CFP · acquired with a Remidio Fundus on Phone (FOP) camera.
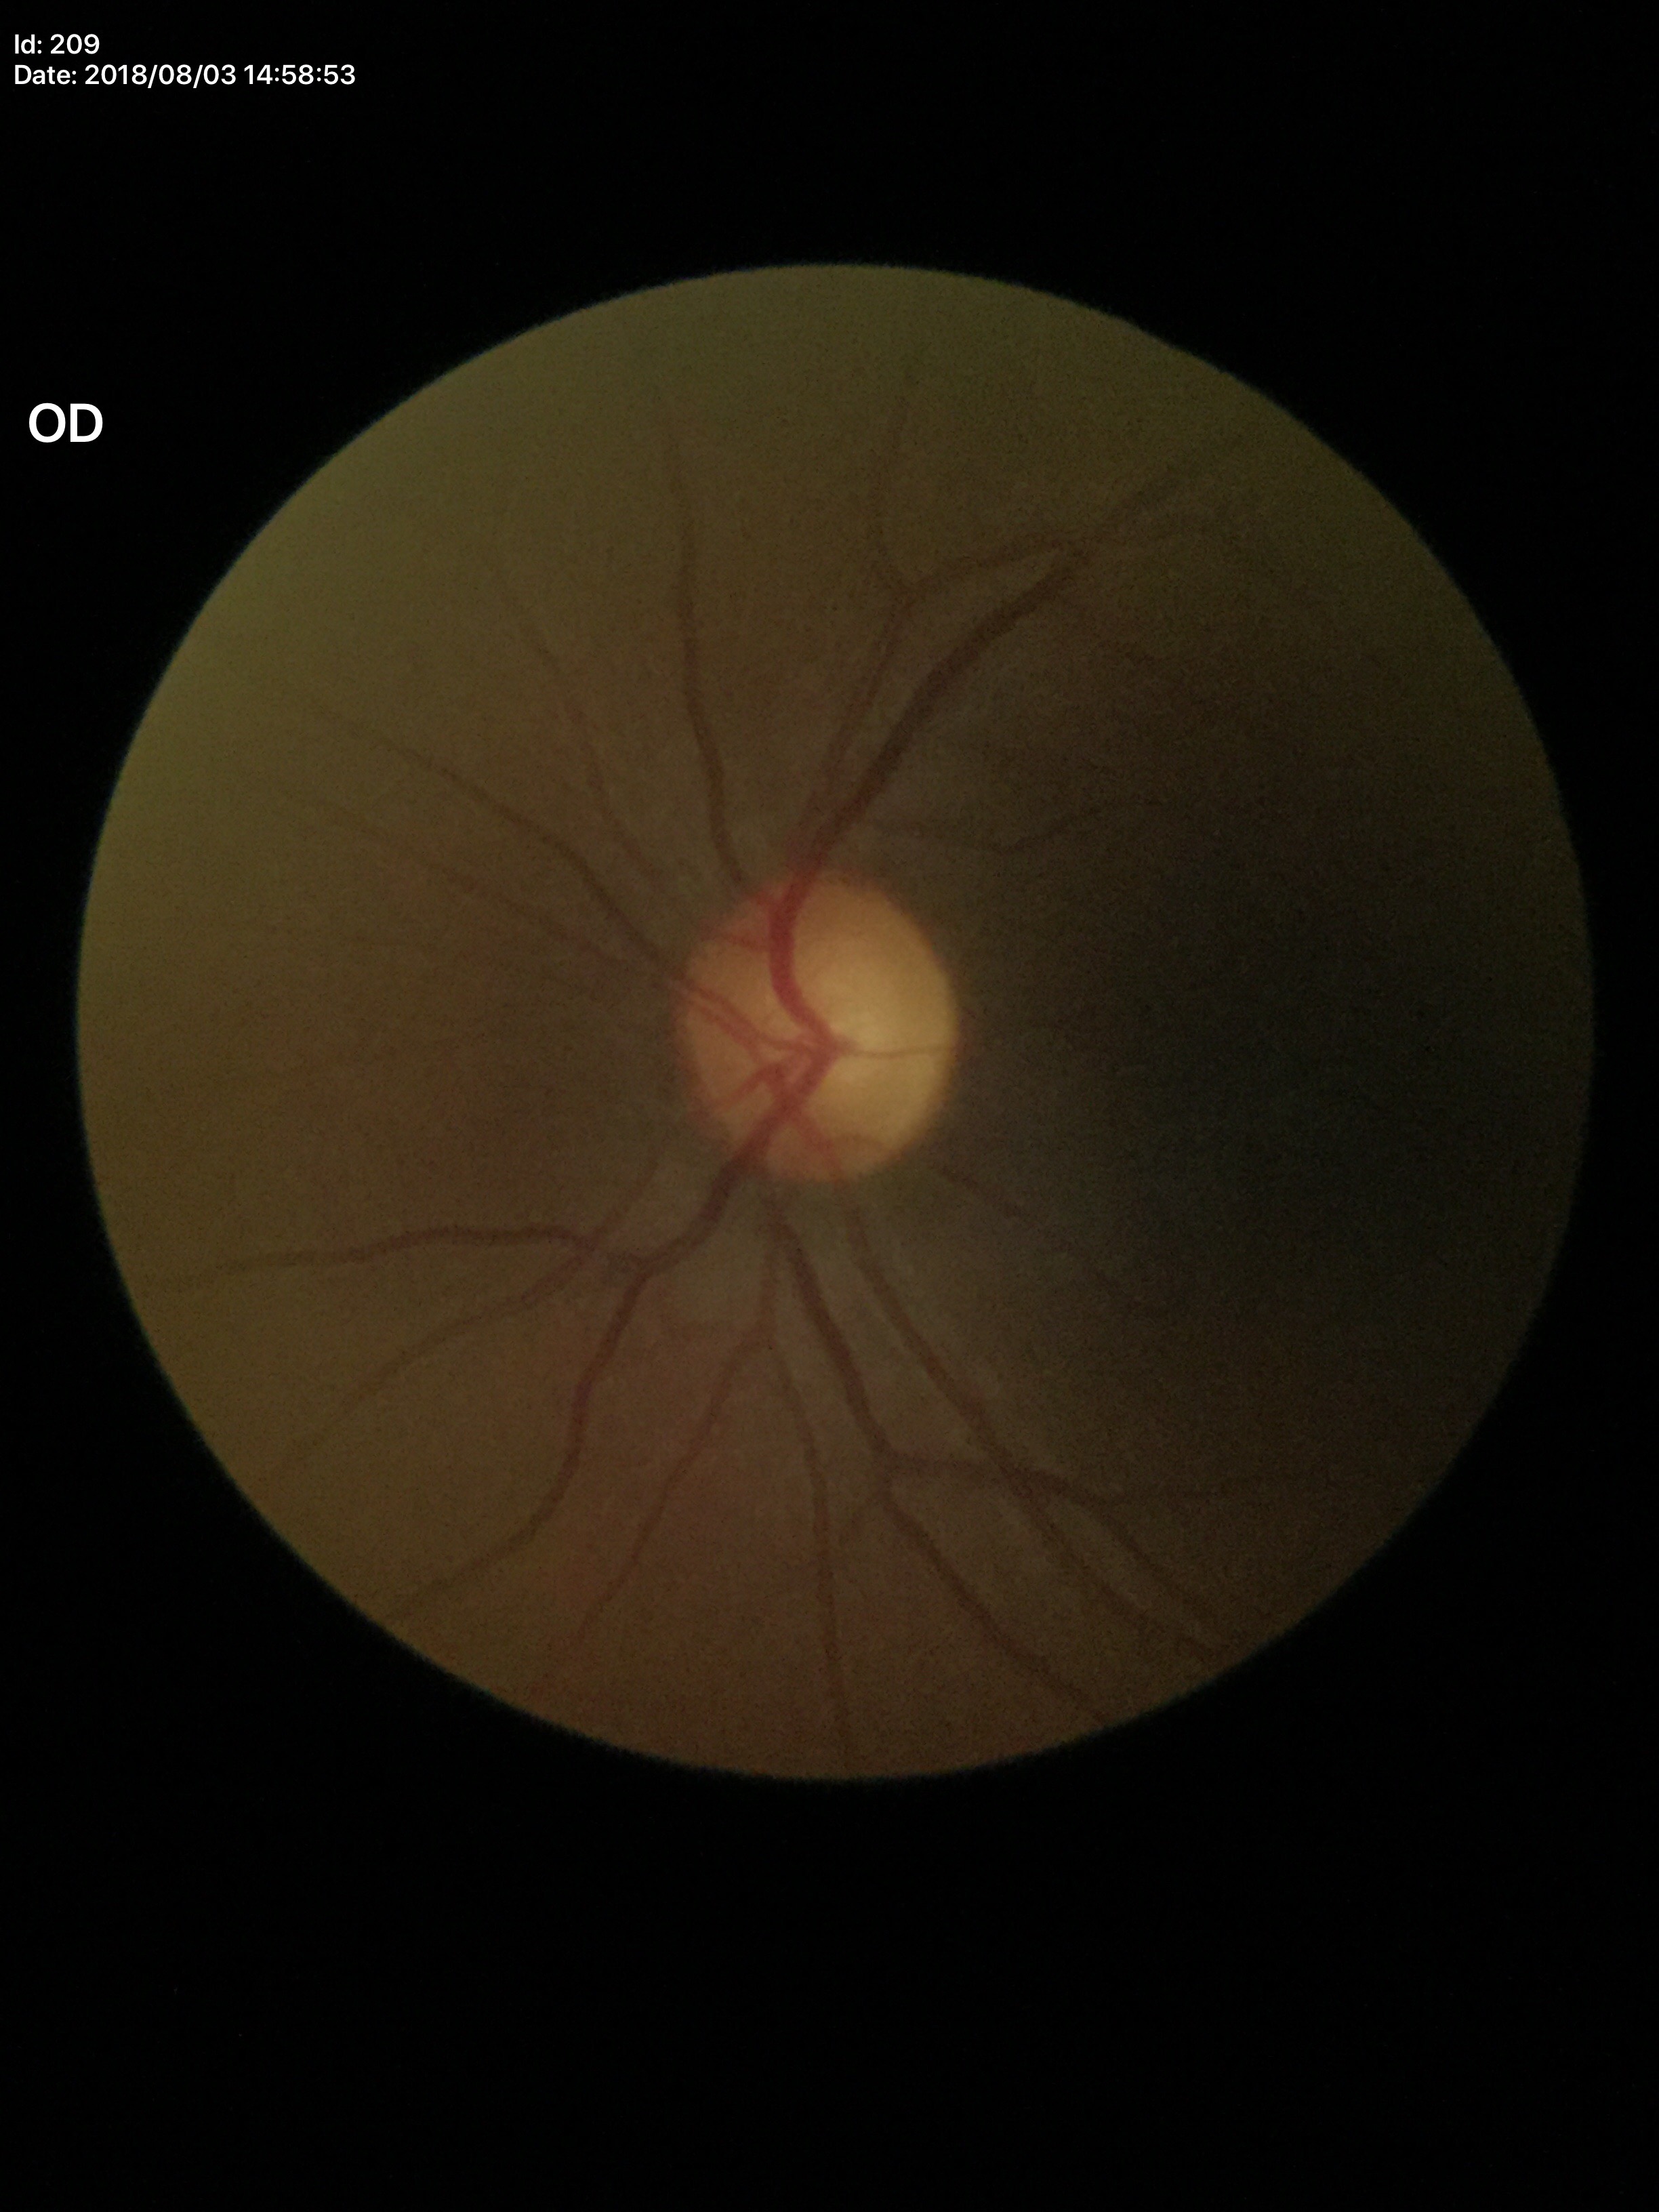 Annotations:
• Glaucoma screening impression — suspicious
• vertical cup-to-disc ratio (VCDR) — 0.61